Image size 2048x1536
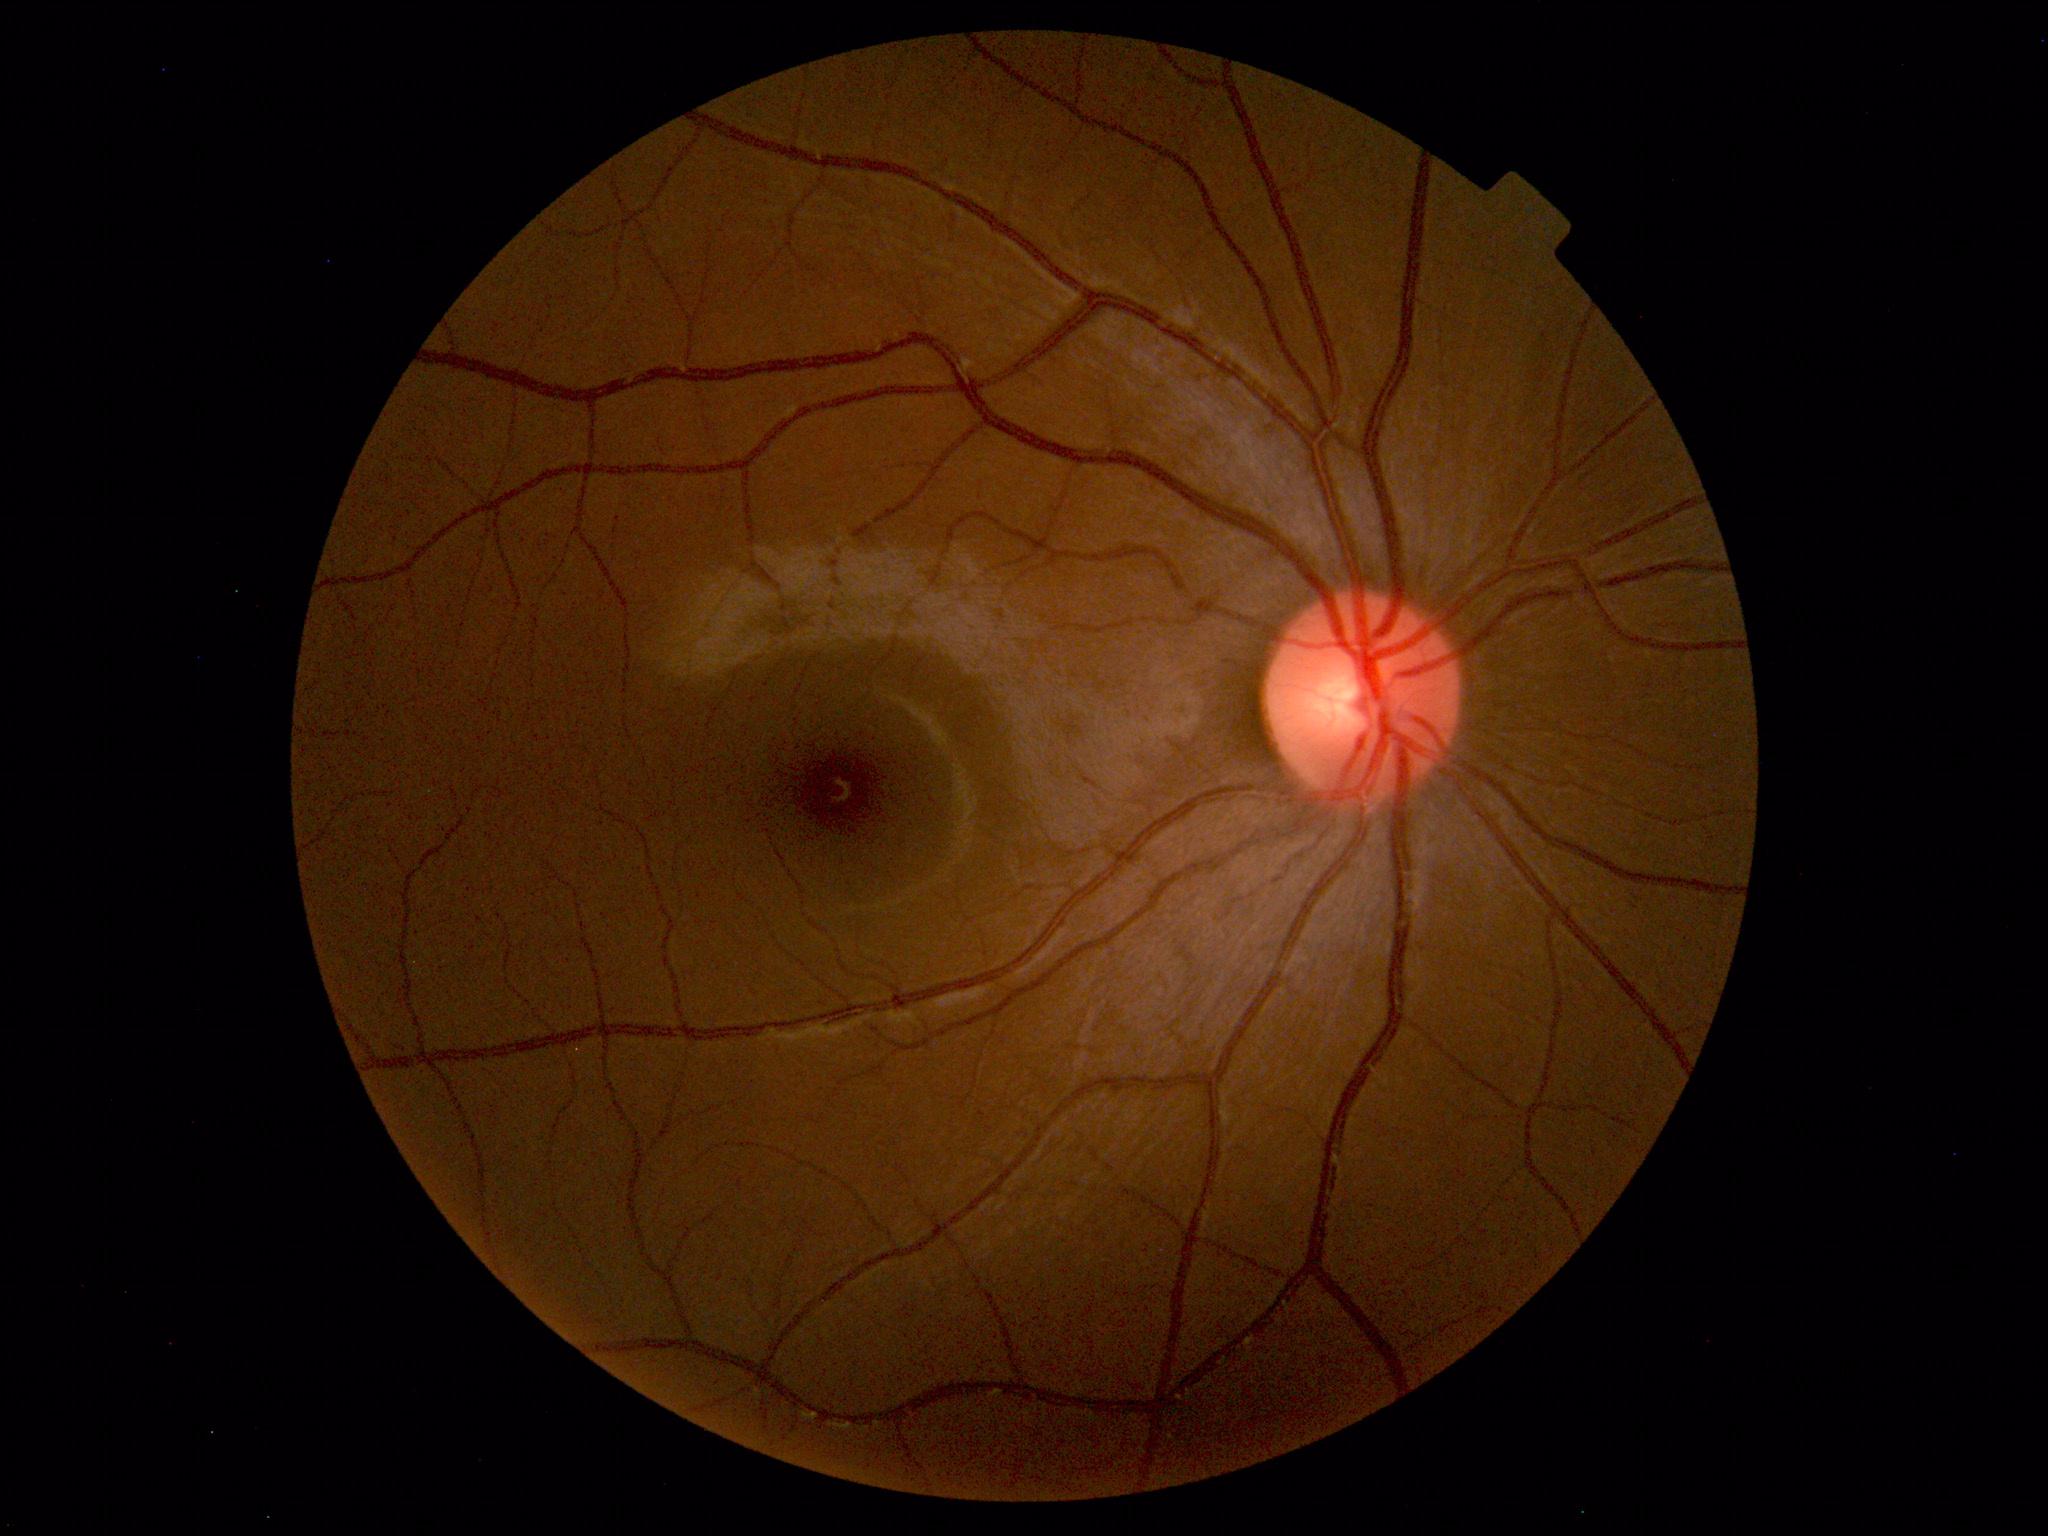
Fundus photograph within normal limits.